NIDEK AFC-230:
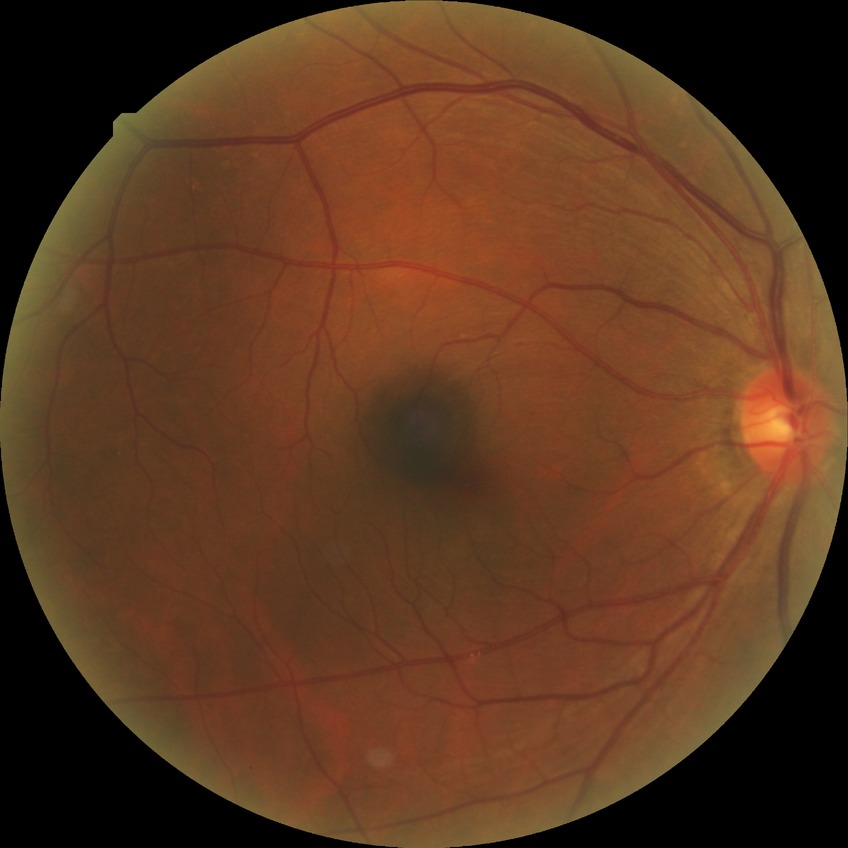
Diabetic retinopathy grade is no diabetic retinopathy.